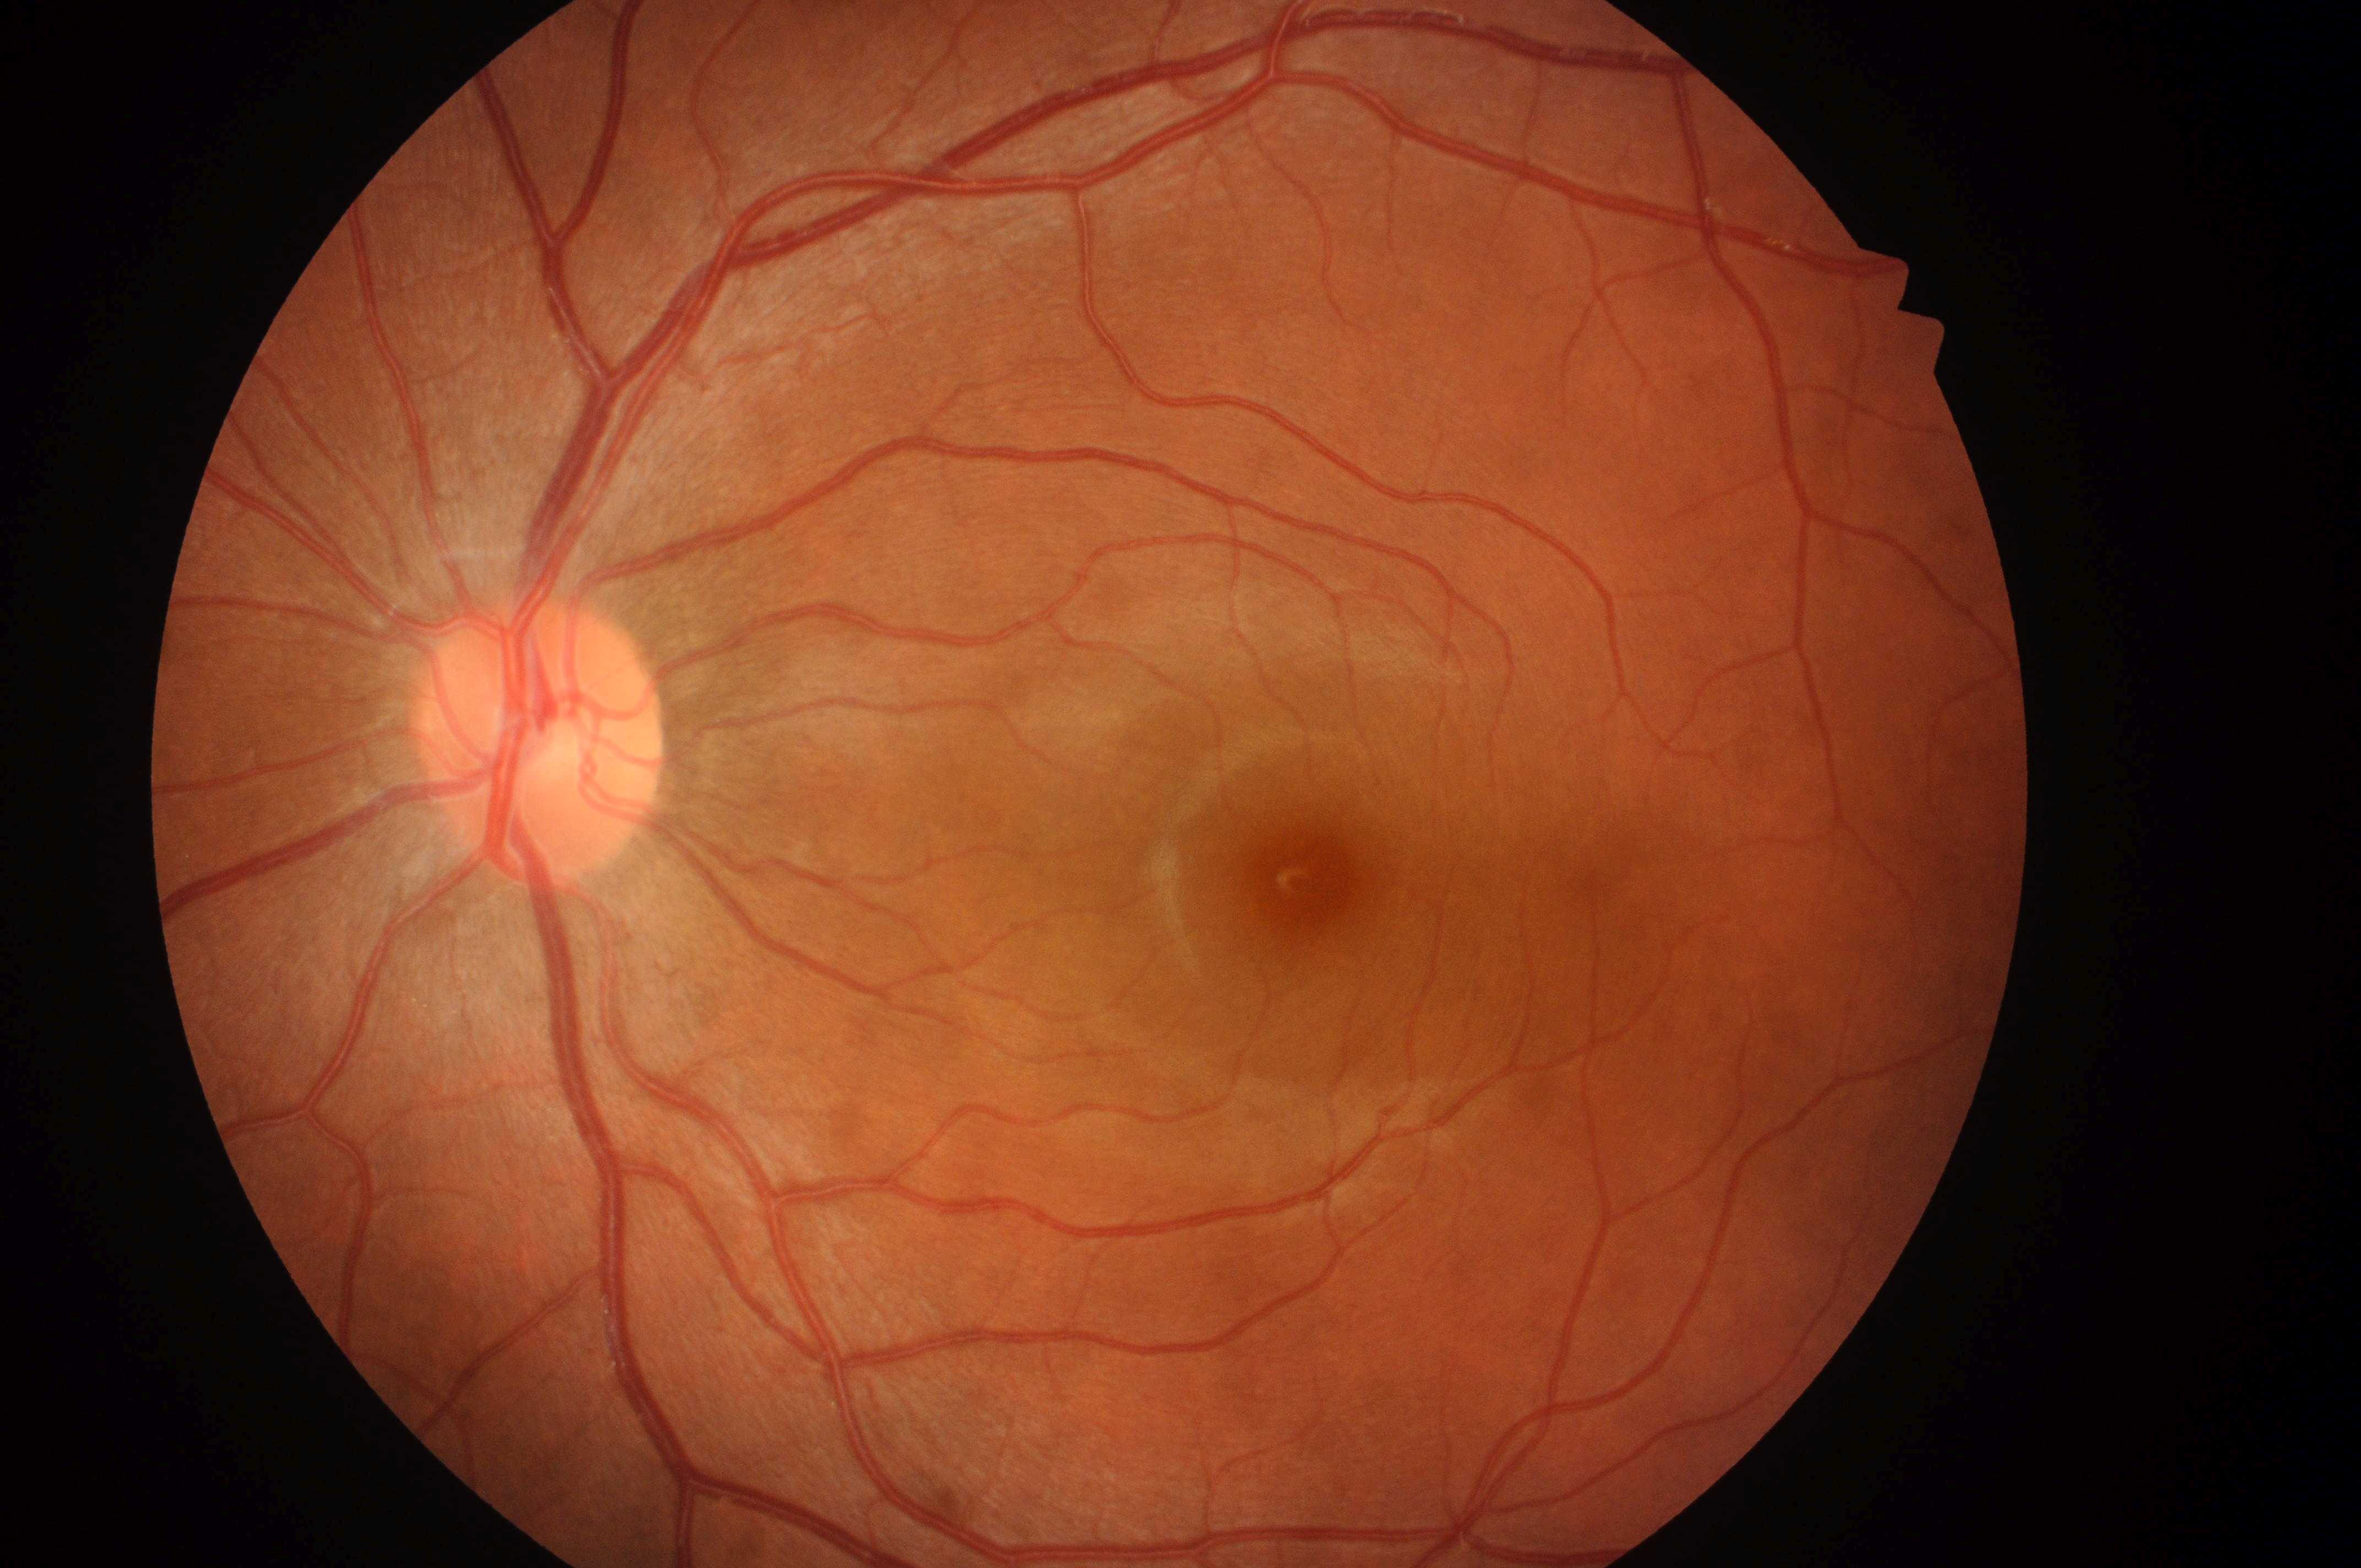
No signs of diabetic retinopathy or diabetic macular edema.
Disc center located at 538px, 756px.
This is the left eye.
The macula center is at 1303px, 884px.
Macular edema is no risk (grade 0).
Retinopathy is grade 0 (no apparent retinopathy).